1536x1152, CFP, 45° FOV — 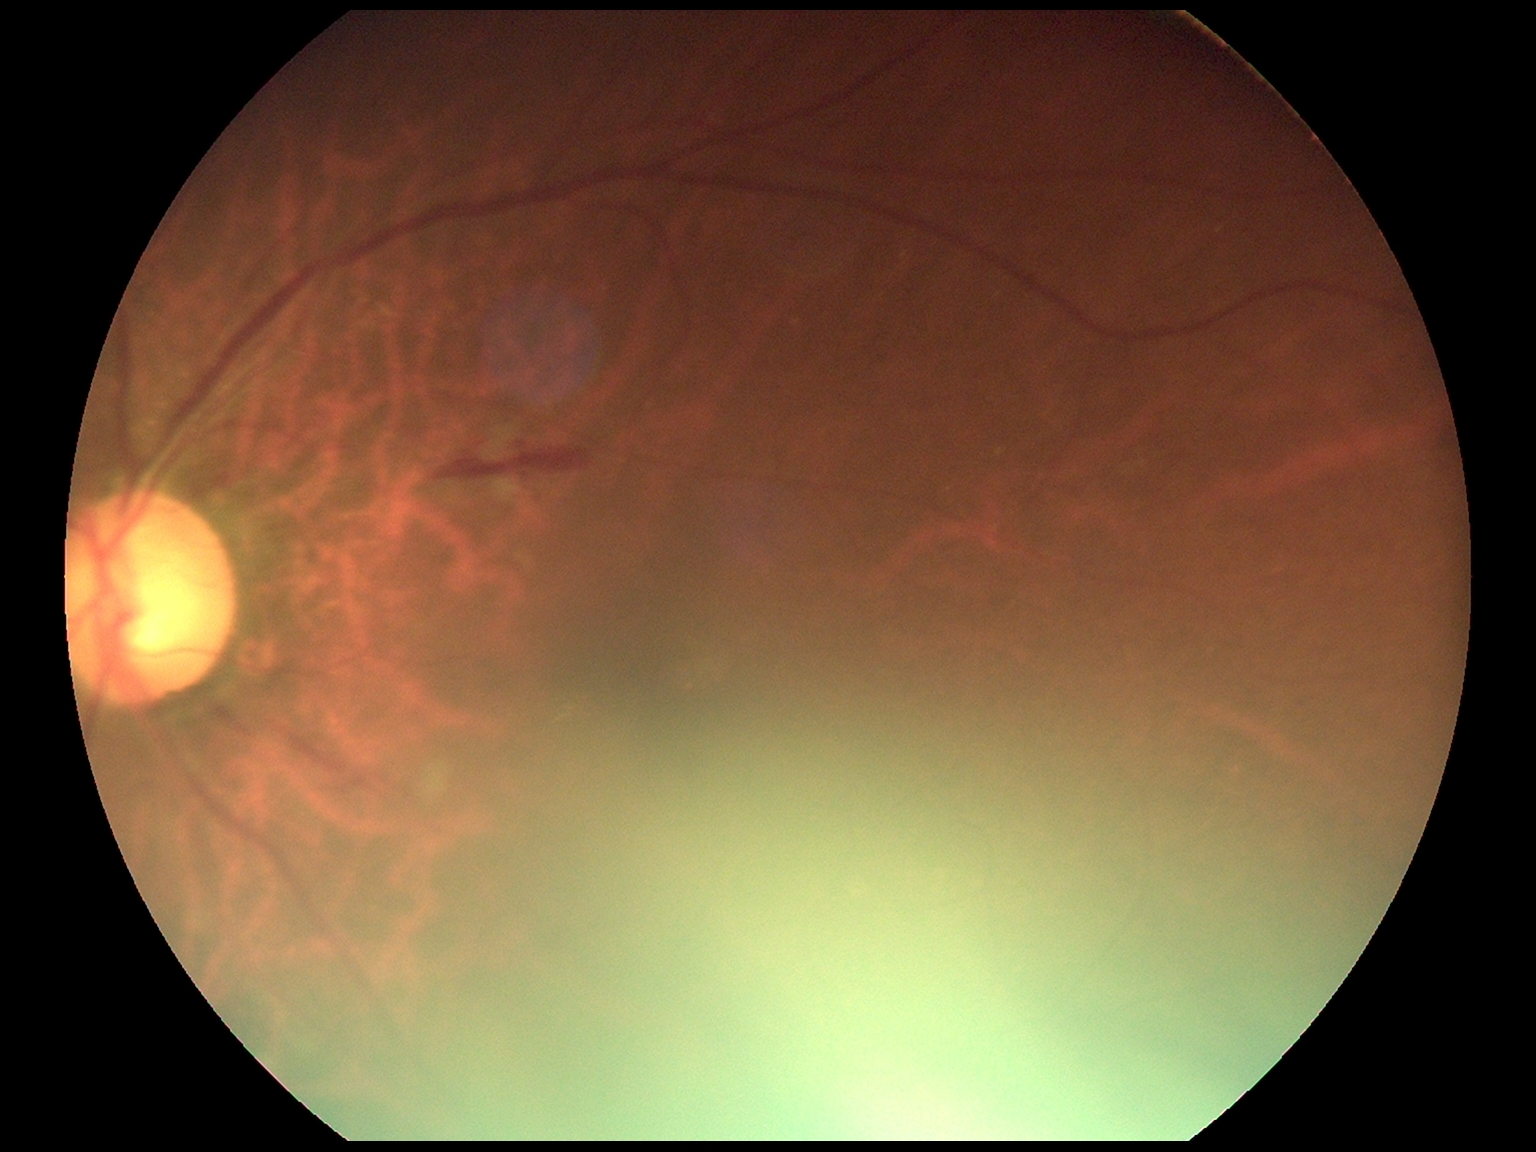
Diabetic retinopathy (DR) is 2/4.